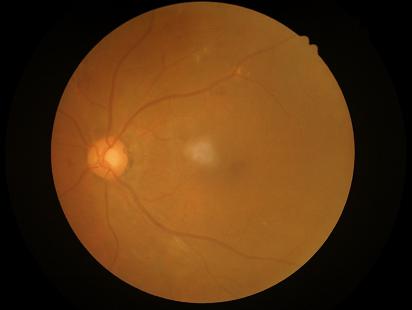

Contrast = adequate | Illumination/color = satisfactory | Overall quality = poor | Clarity = out of focus.